45° field of view; retinal fundus photograph; no pharmacologic dilation; Davis DR grading: 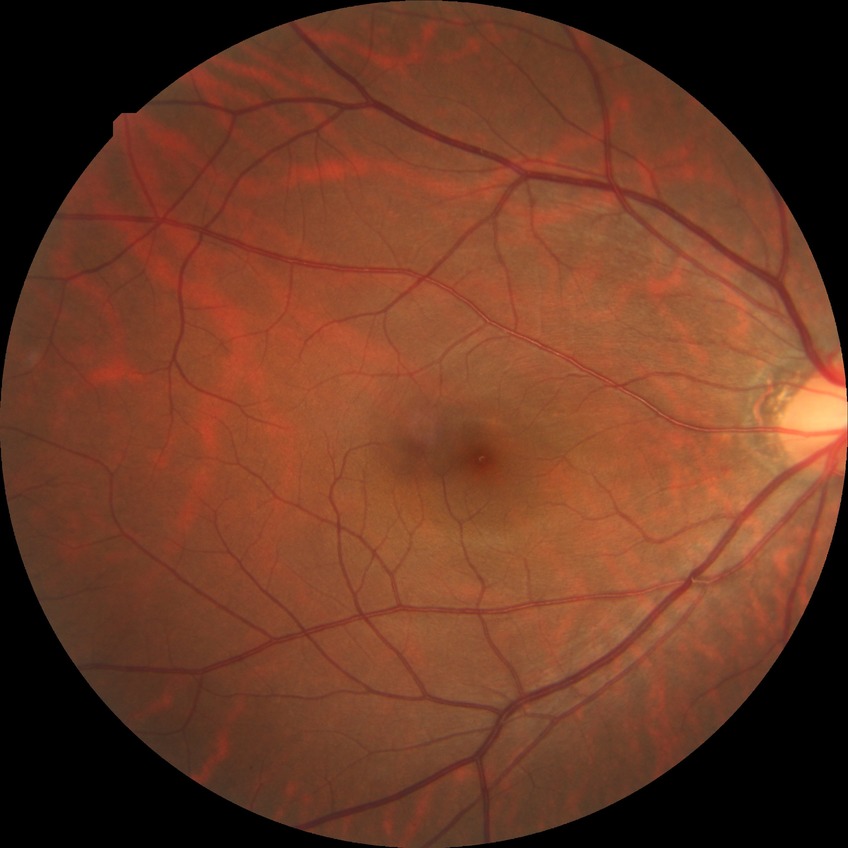
Findings:
• diabetic retinopathy stage — no diabetic retinopathy